Image size 1240x1240; camera: Phoenix ICON (100° FOV); wide-field contact fundus photograph of an infant: 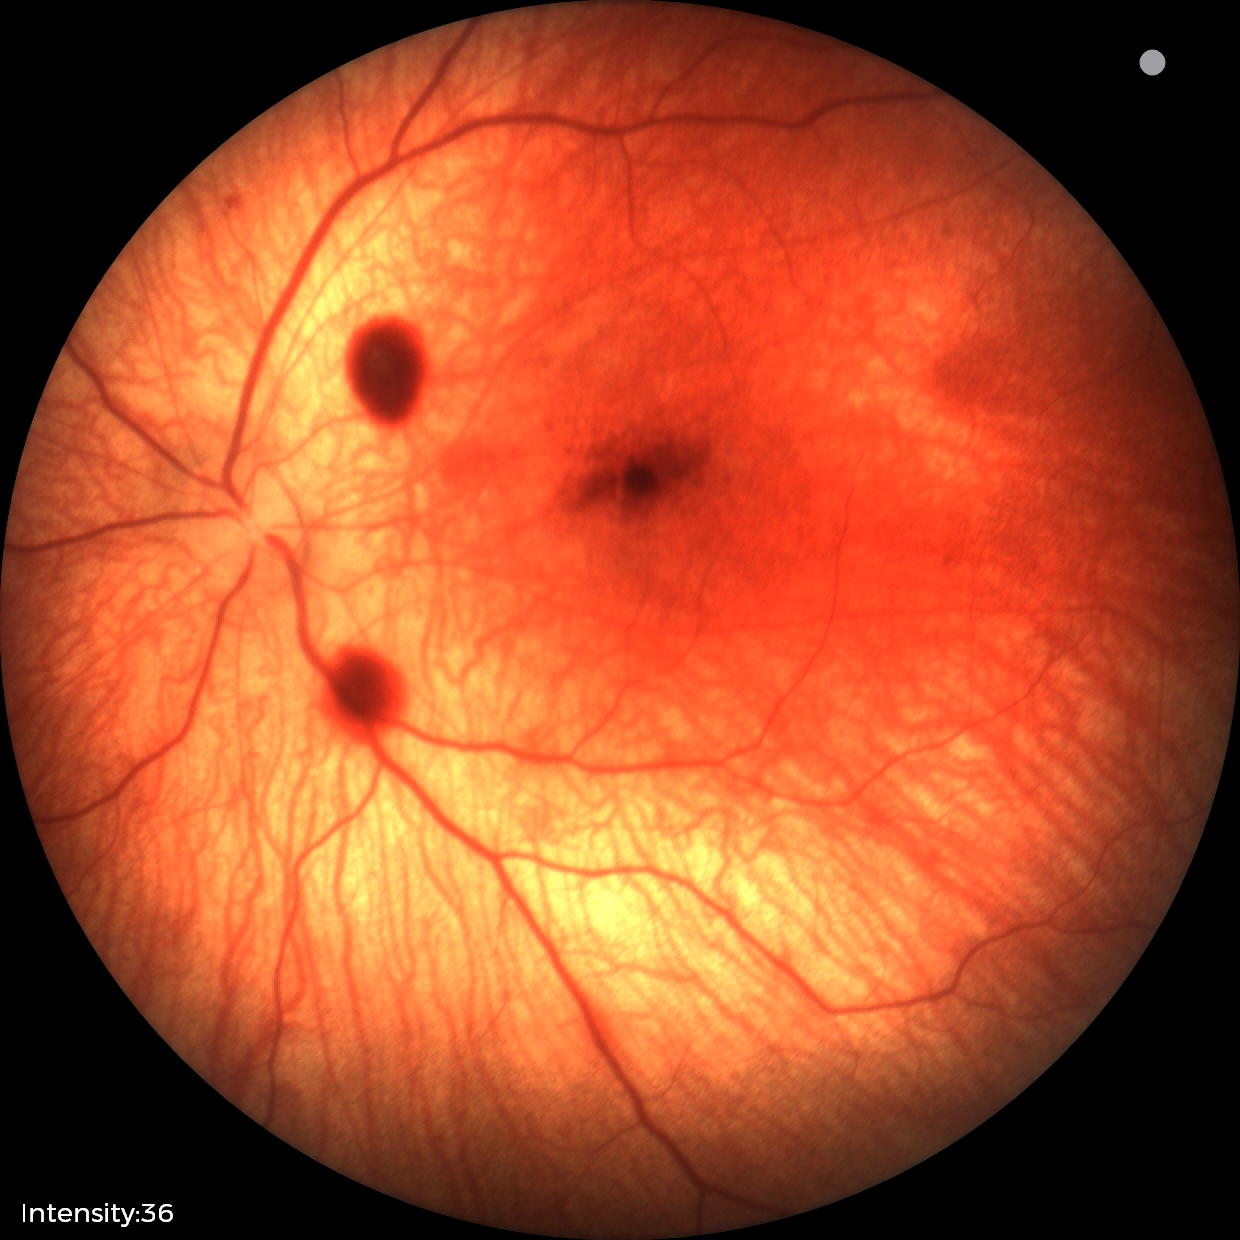

Q: What was the screening finding?
A: retinal hemorrhages